Captured with the Phoenix ICON (100° field of view); wide-field contact fundus photograph of an infant; image size 1240x1240.
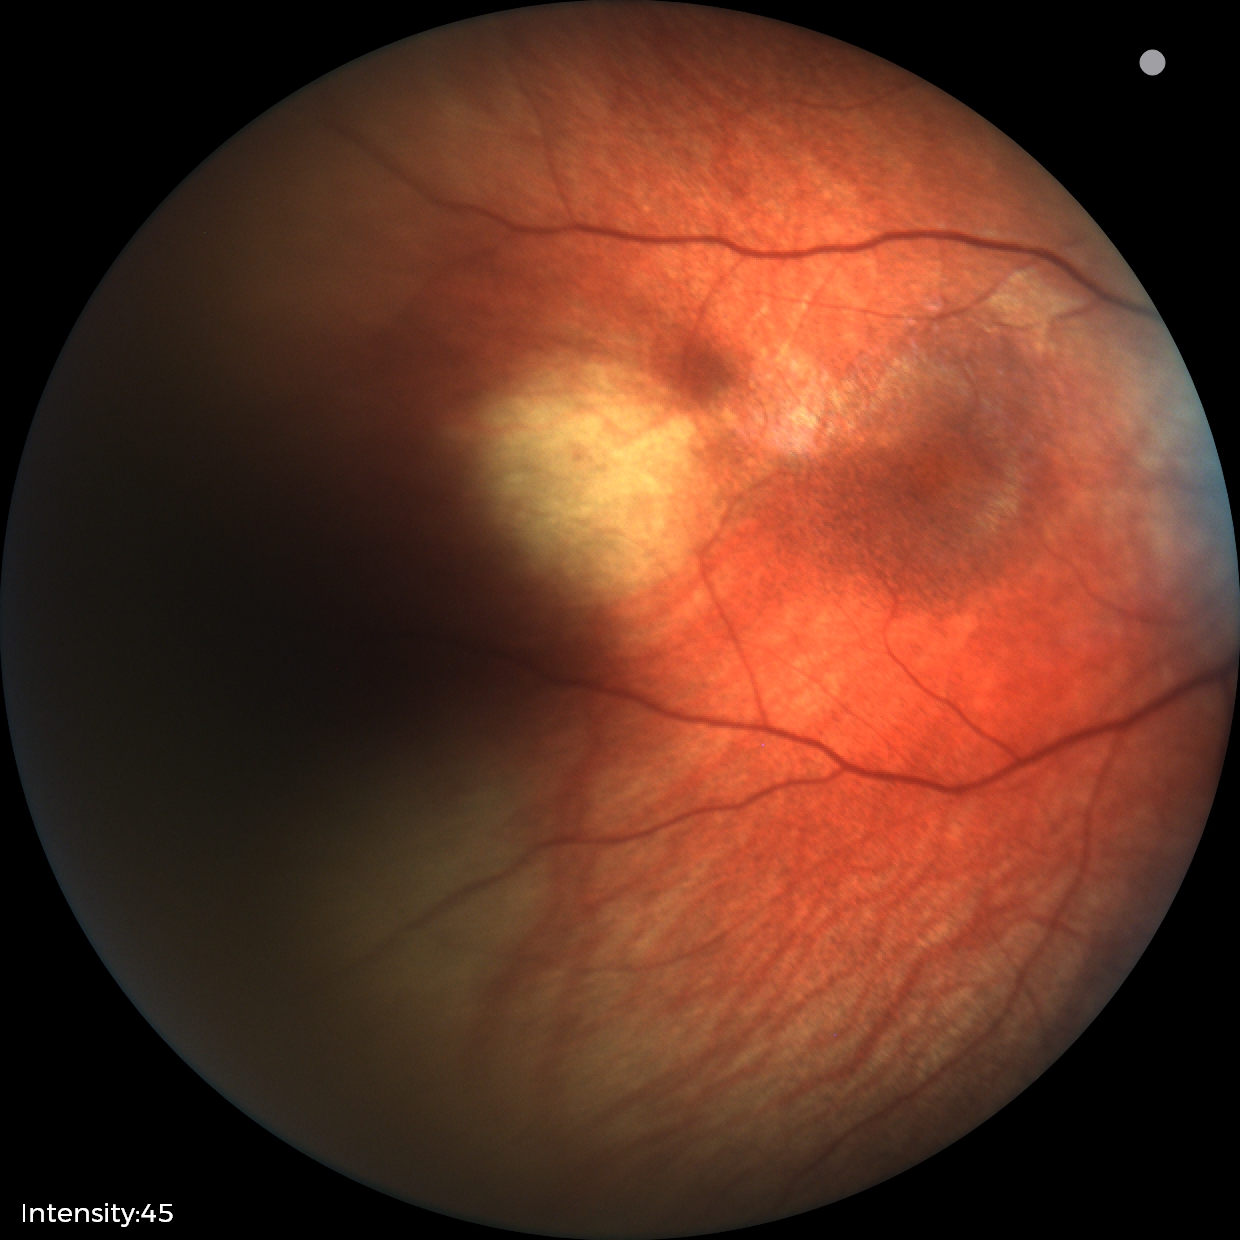 Q: What was the screening finding?
A: no abnormal retinal findings